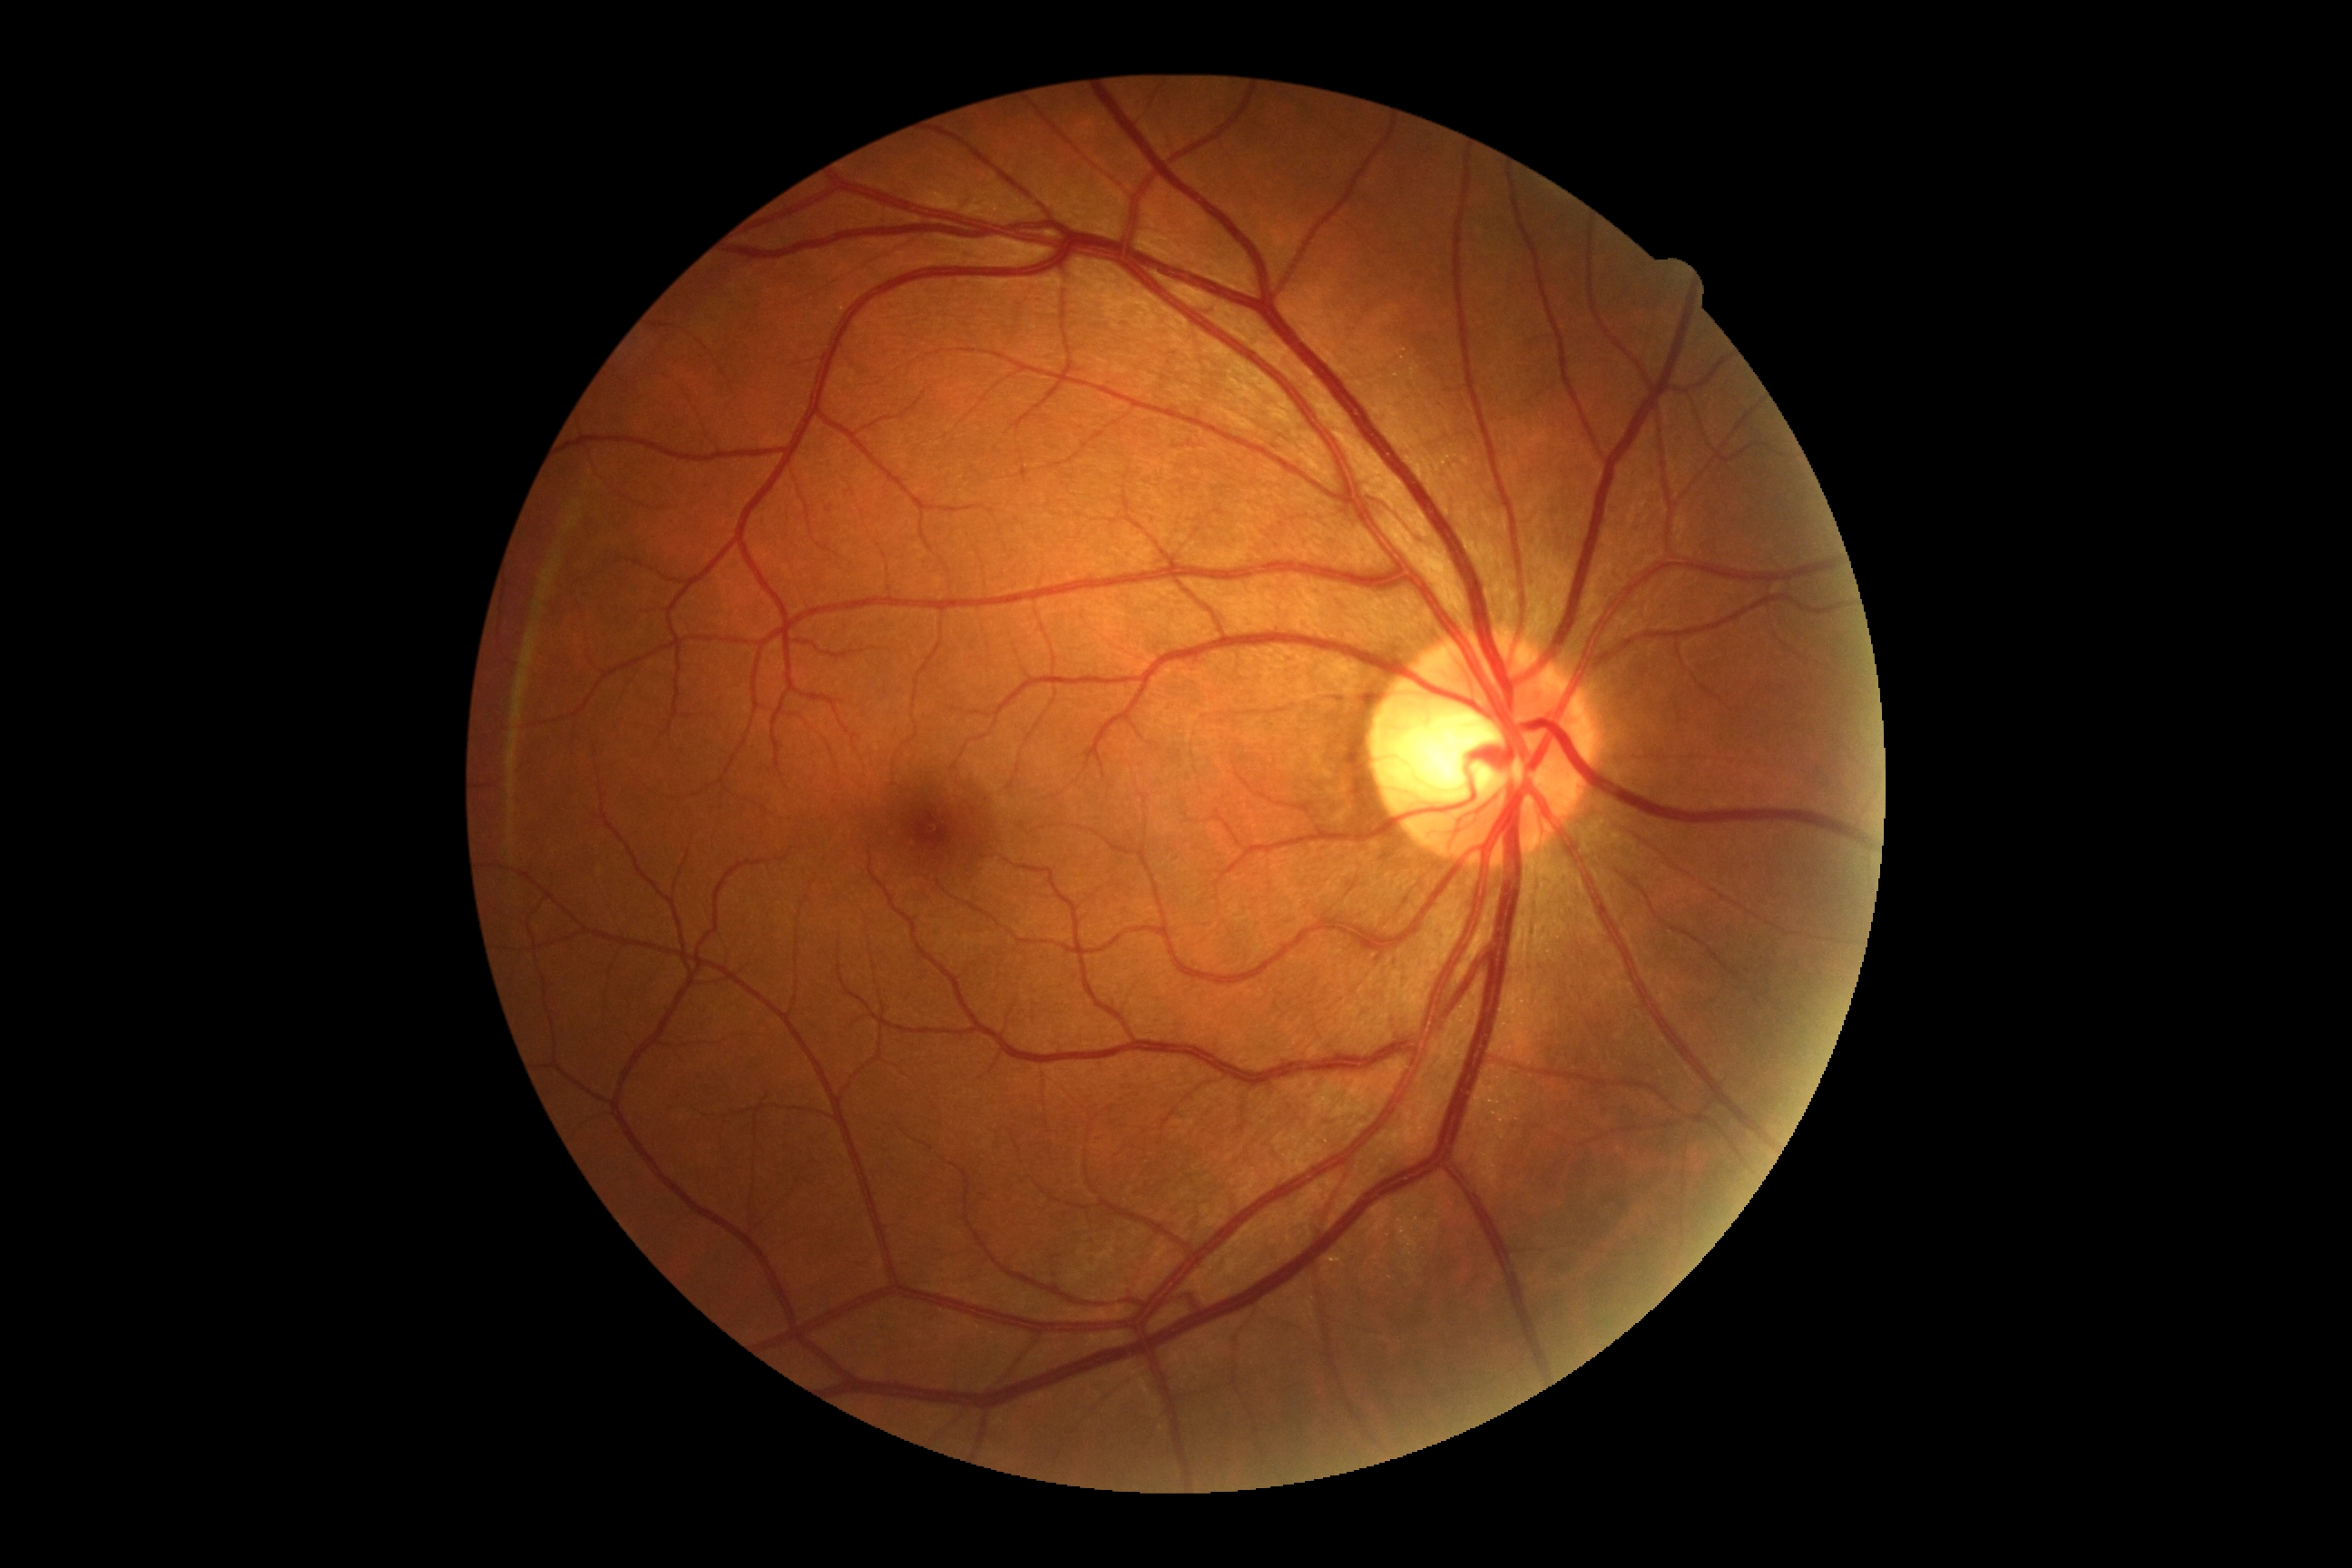 Annotations:
– diabetic retinopathy severity: 0